FOV: 45 degrees:
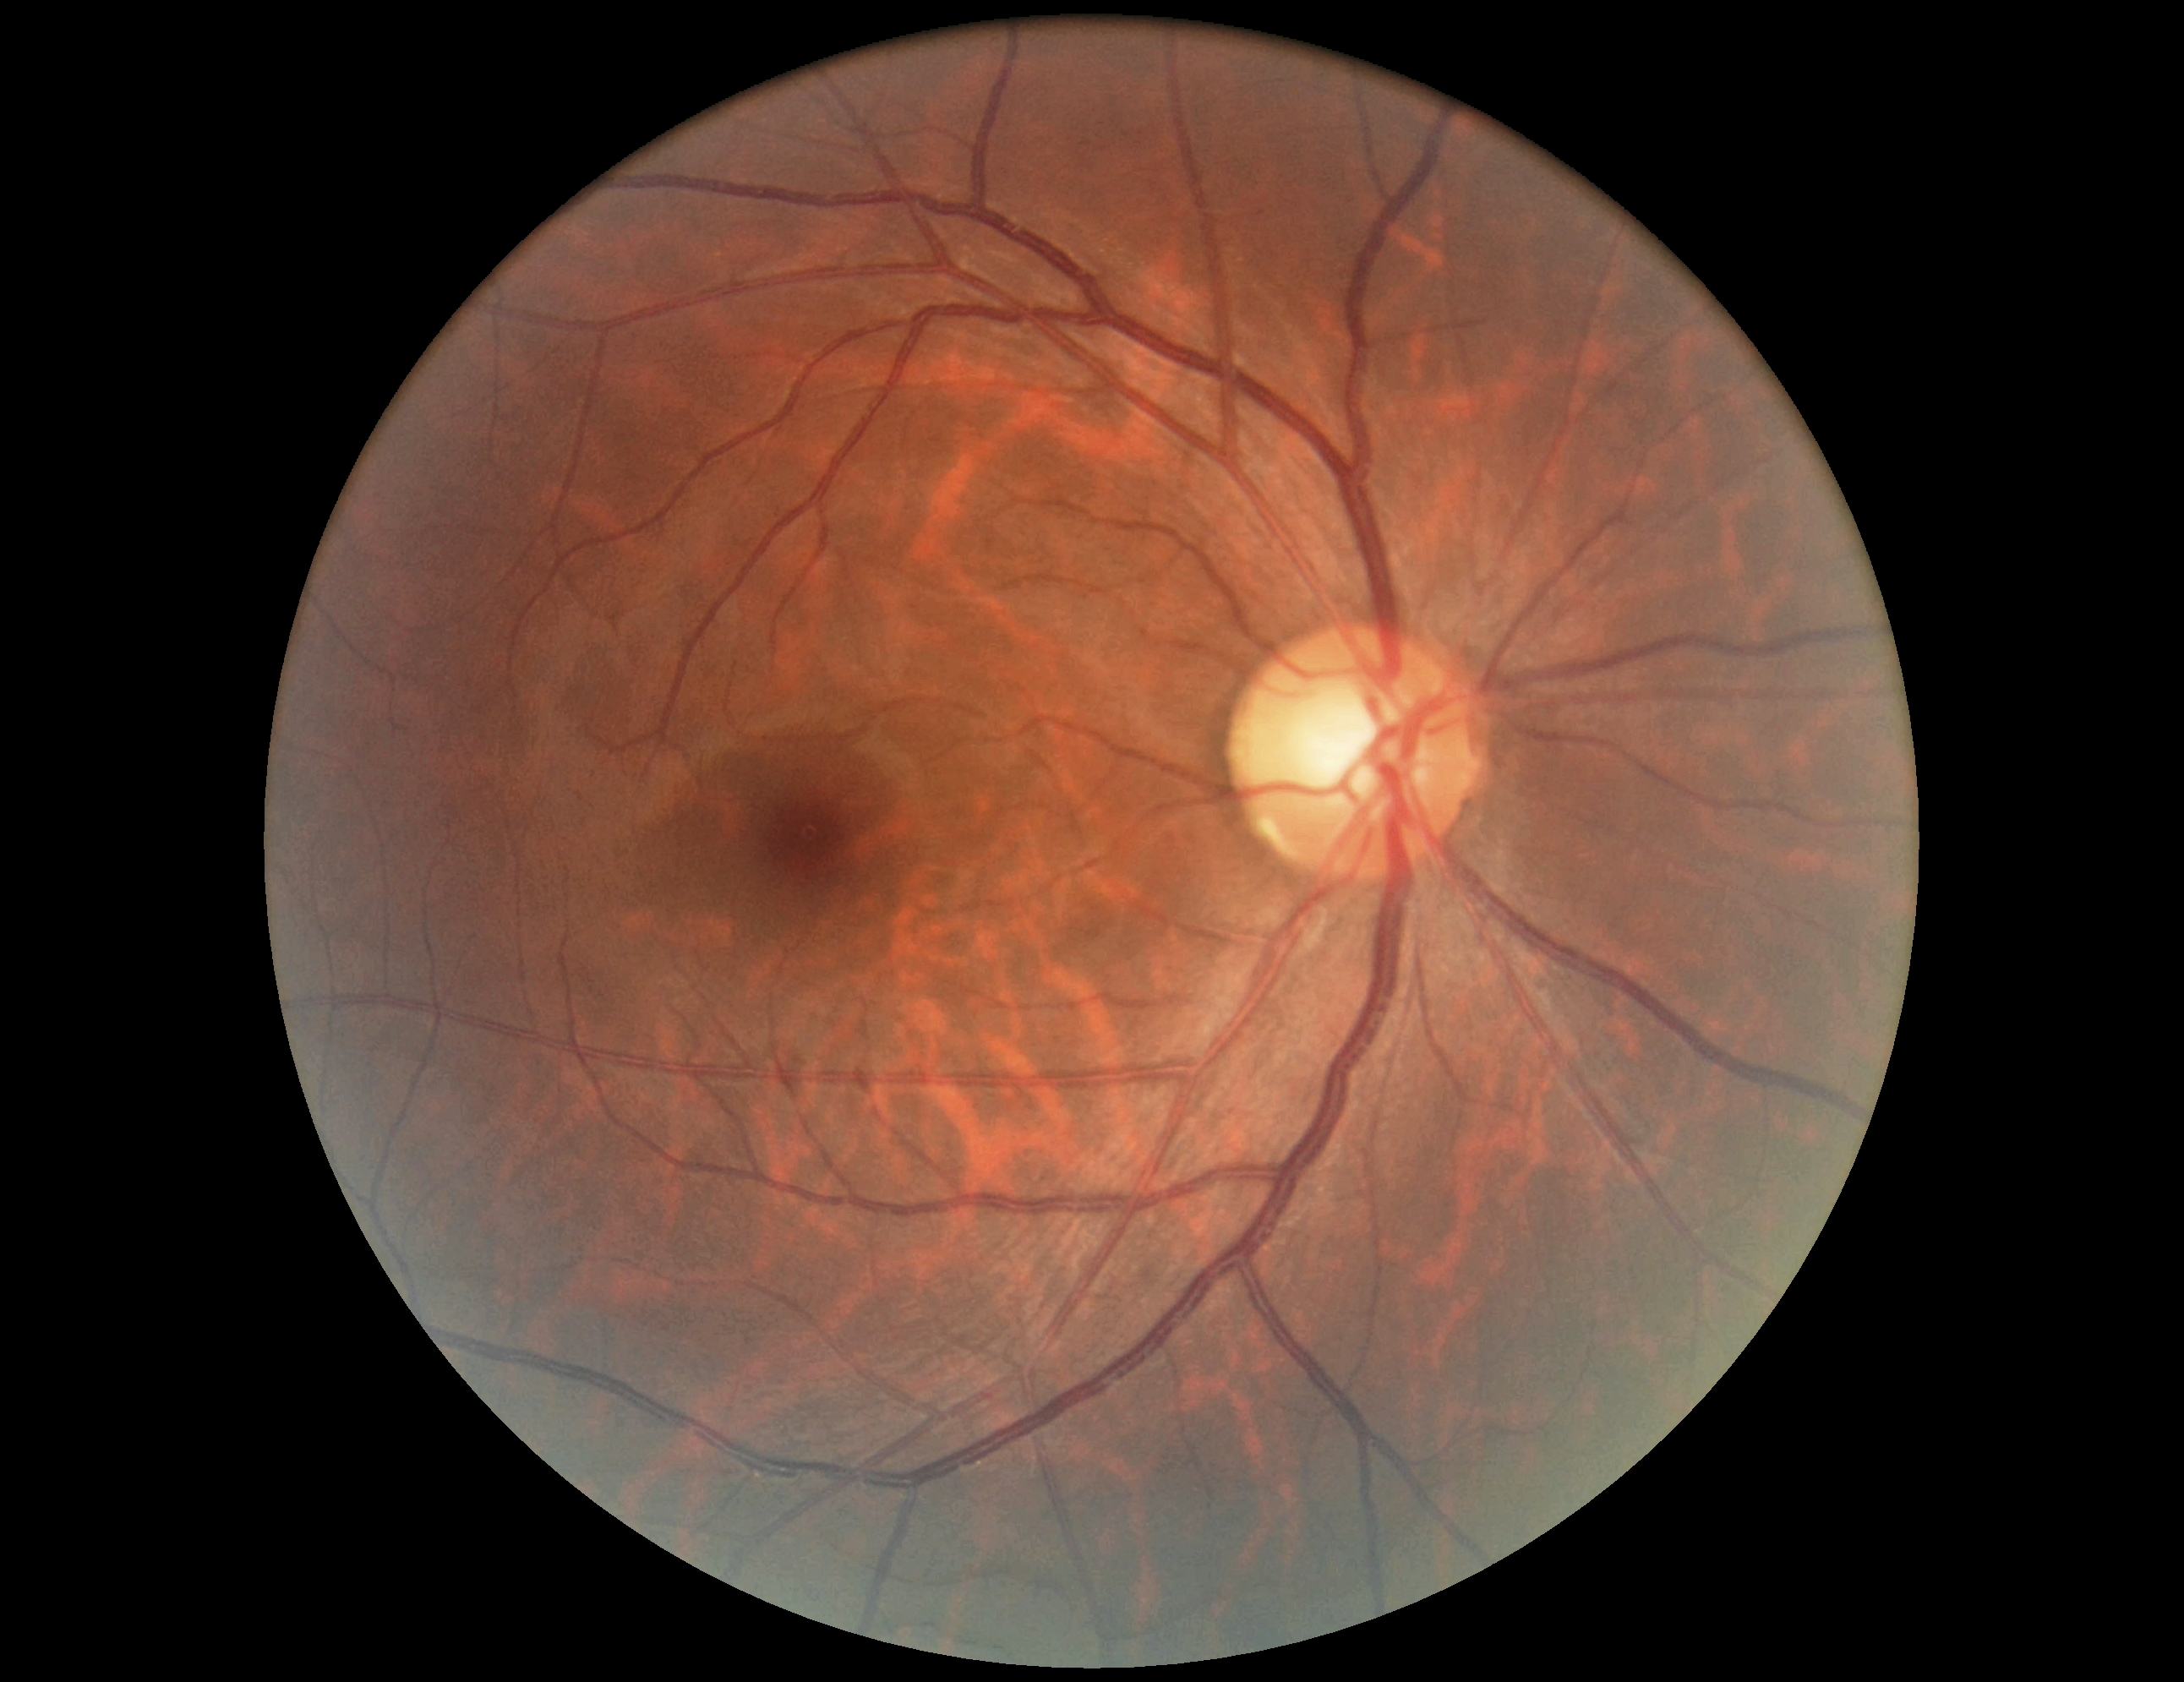
  dr_grade: no apparent diabetic retinopathy (grade 0)